FOV: 45 degrees; fundus photo
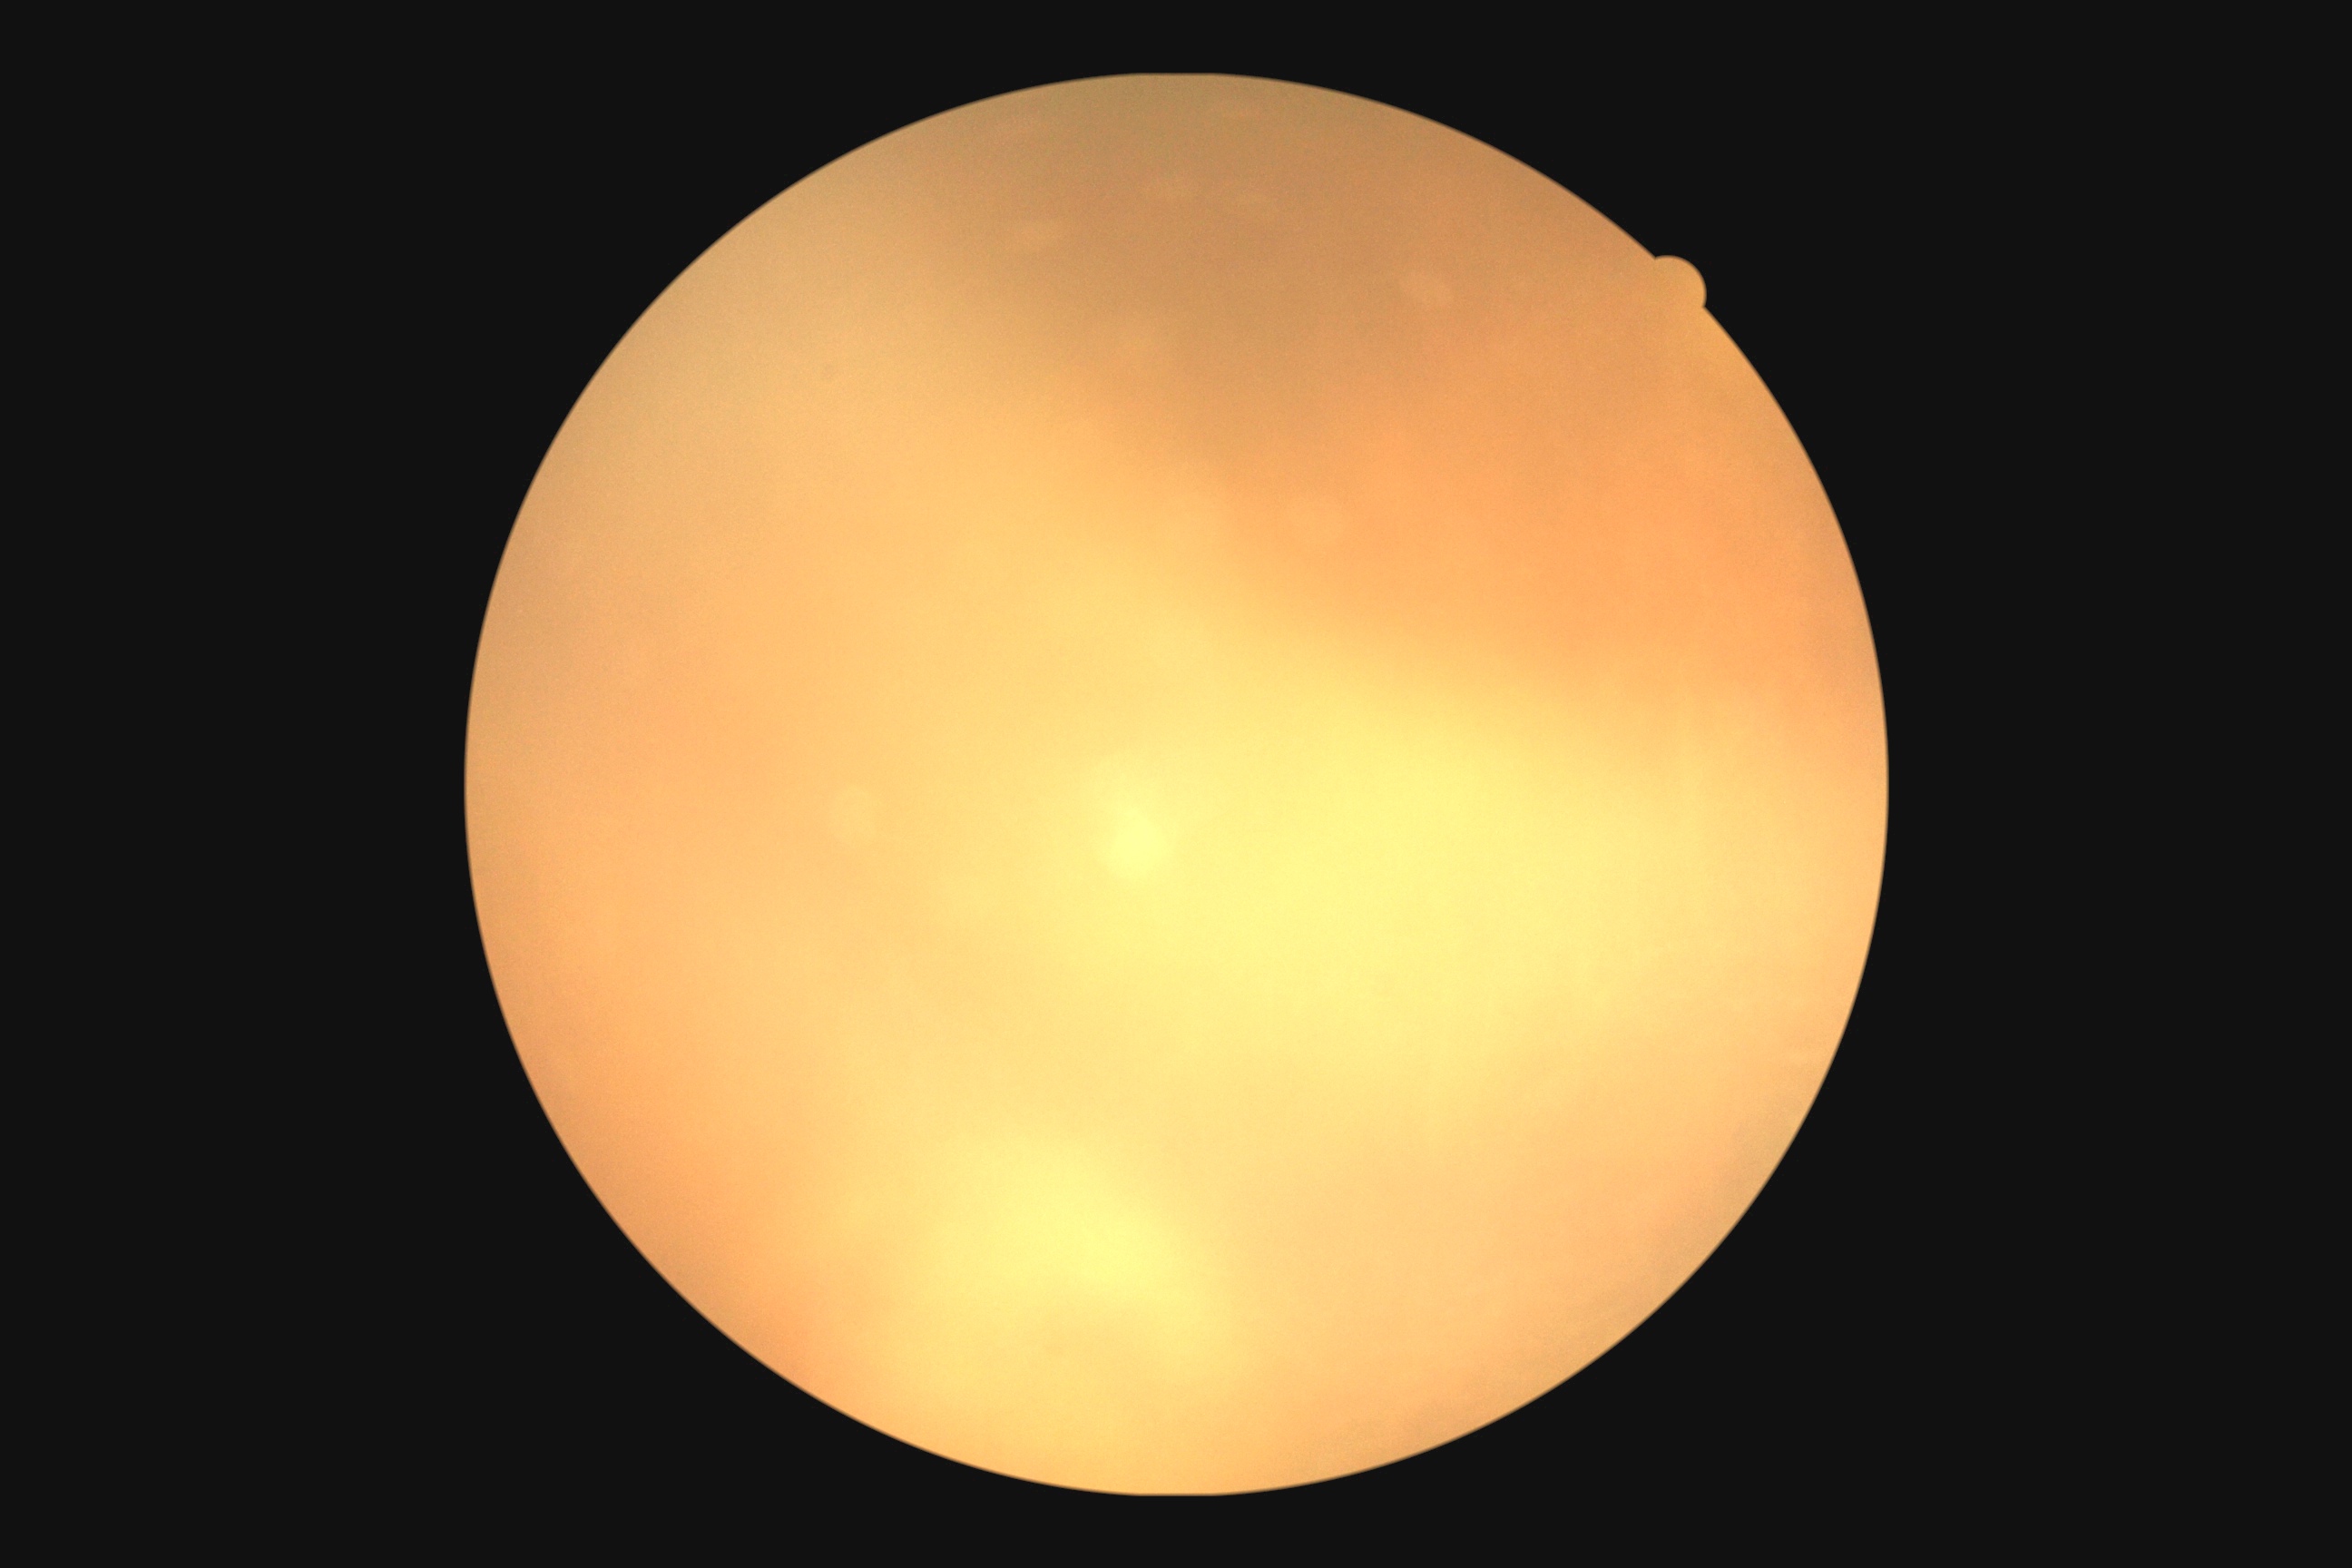 Ungradable image — DR severity cannot be determined.
Retinopathy grade: ungradable due to poor image quality.